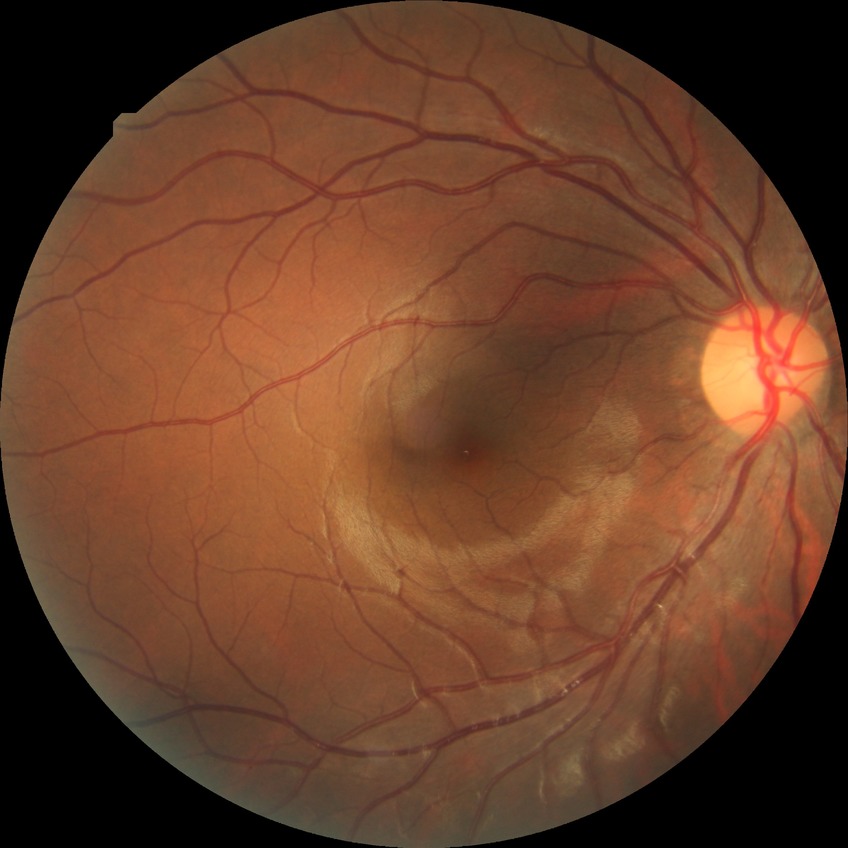 Davis grading: no diabetic retinopathy.